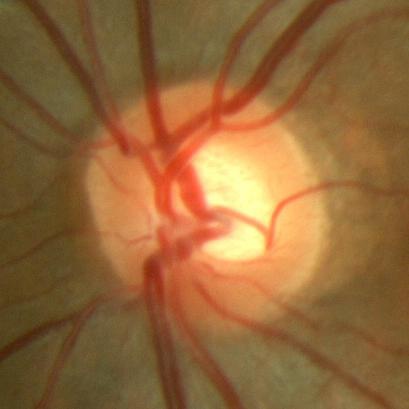

No glaucomatous damage.